45° FOV · color fundus image:
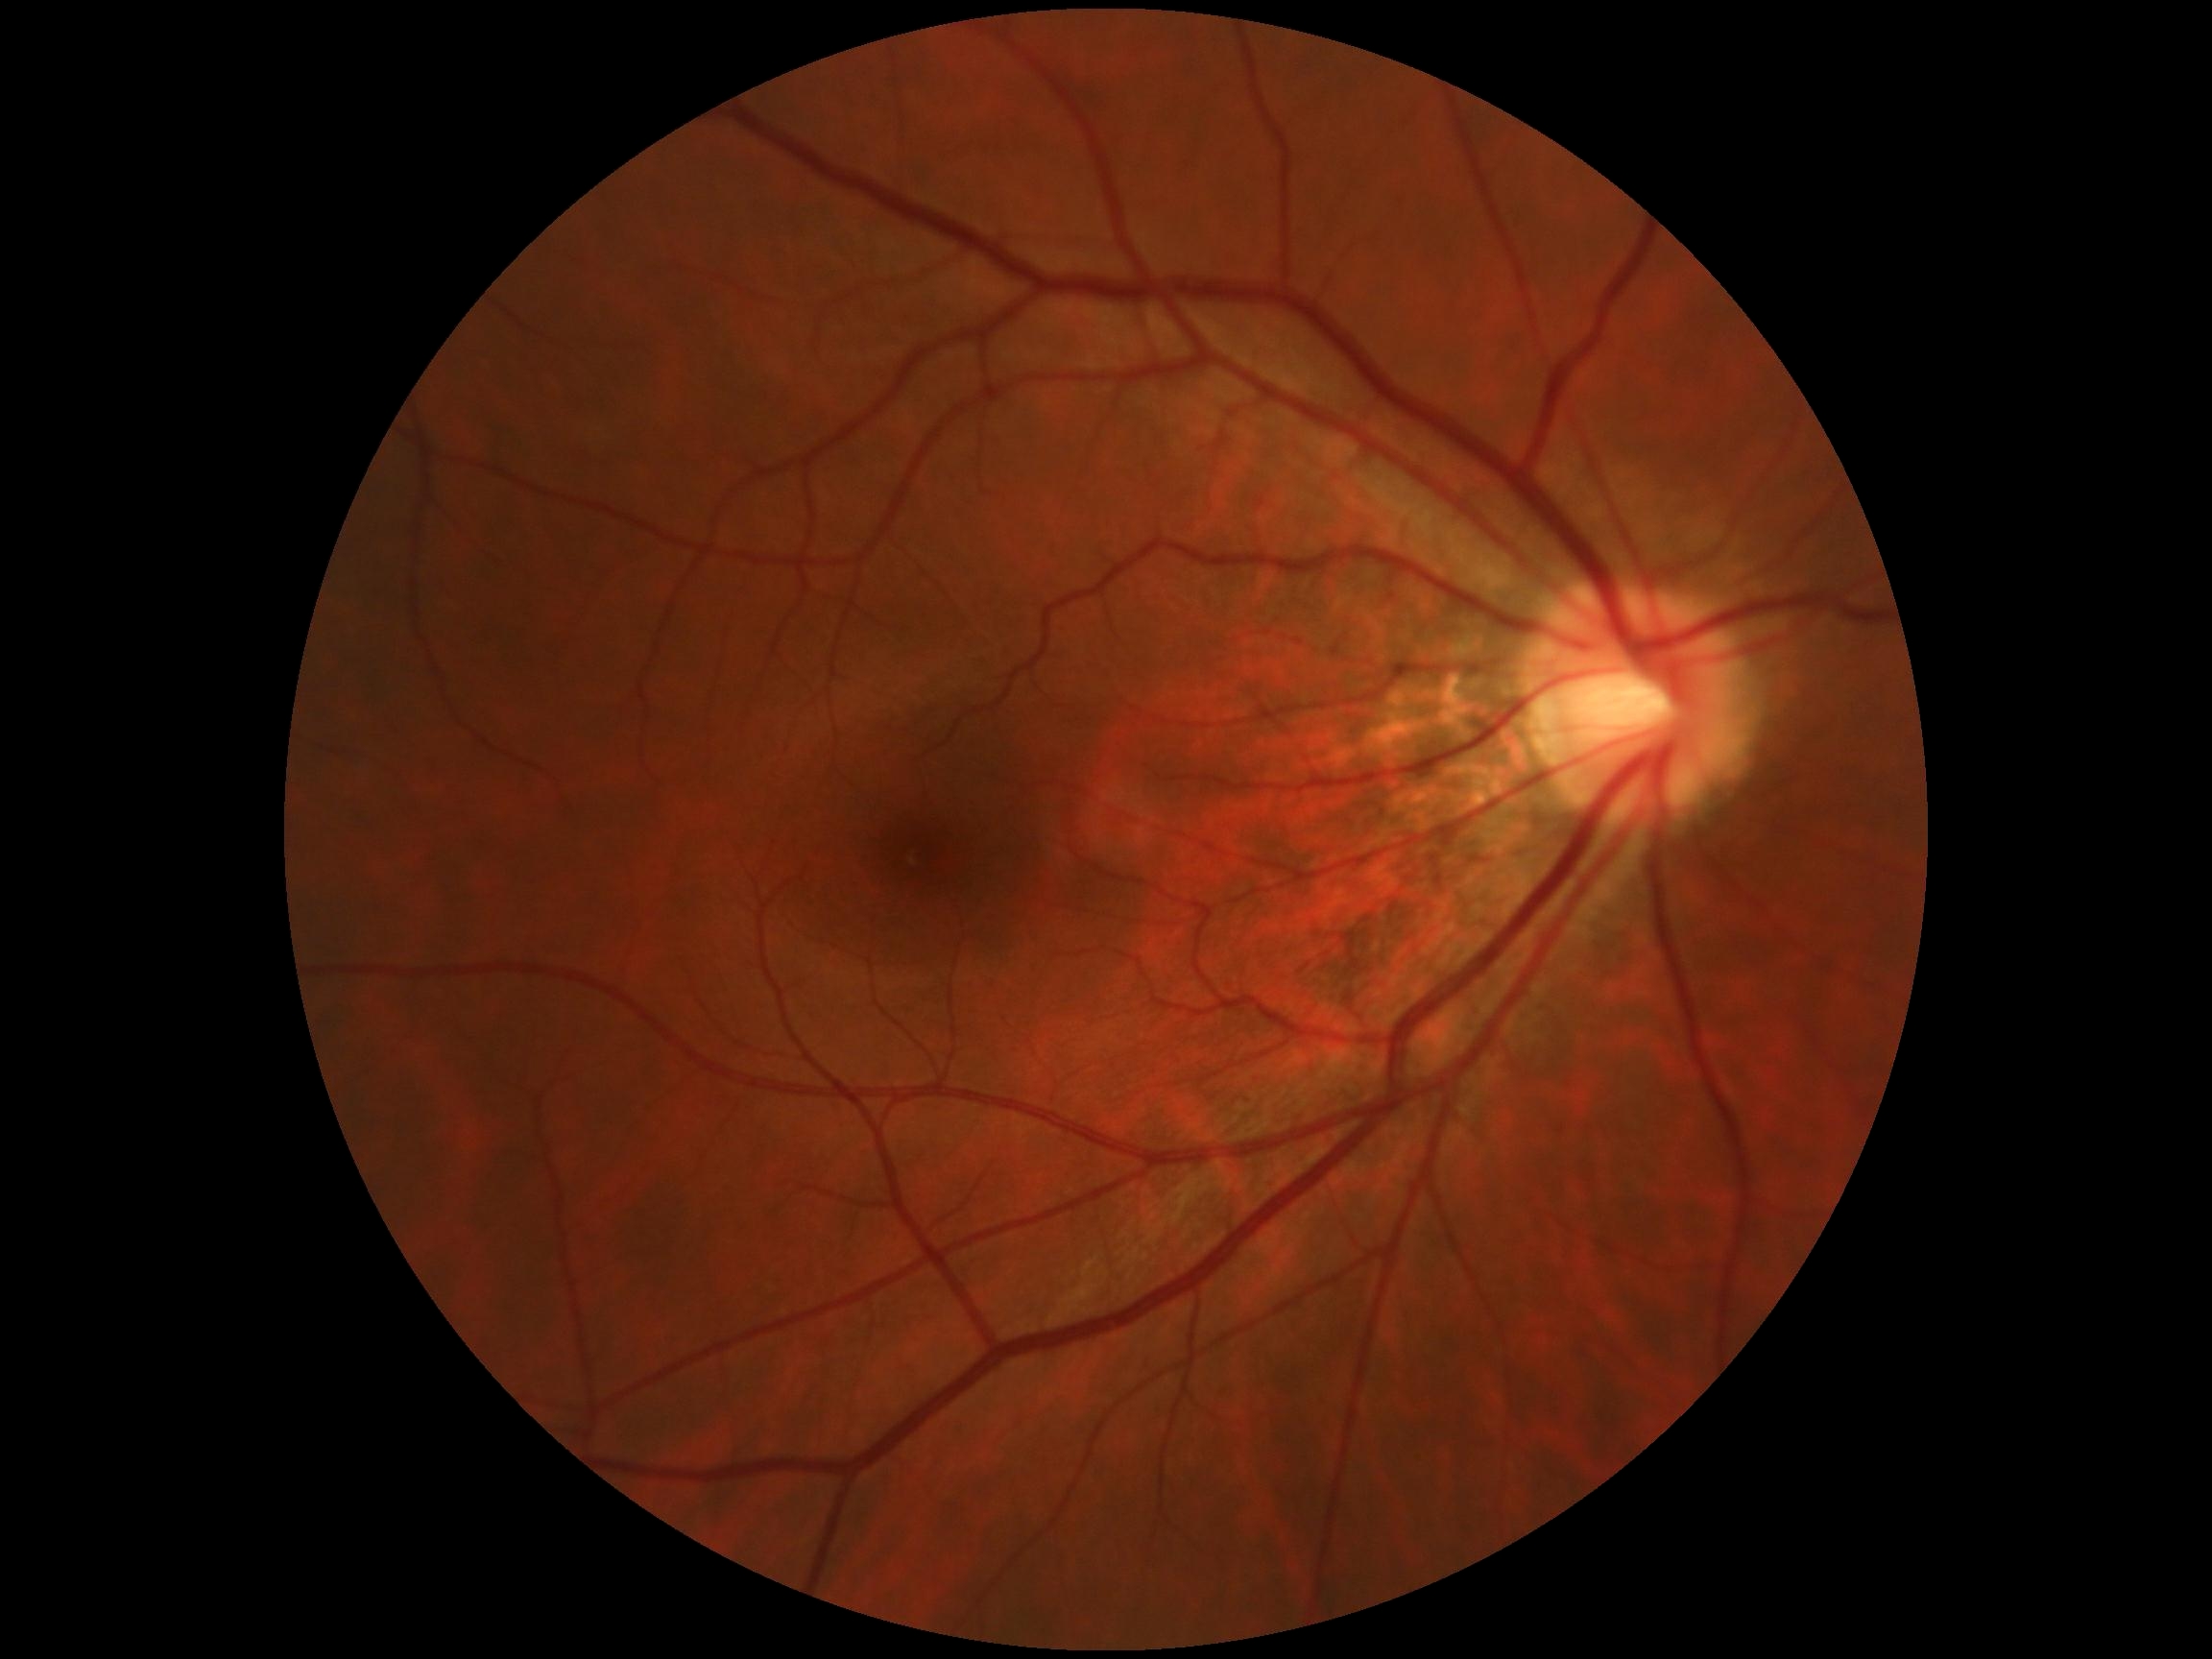 DR grade is no apparent diabetic retinopathy (0).